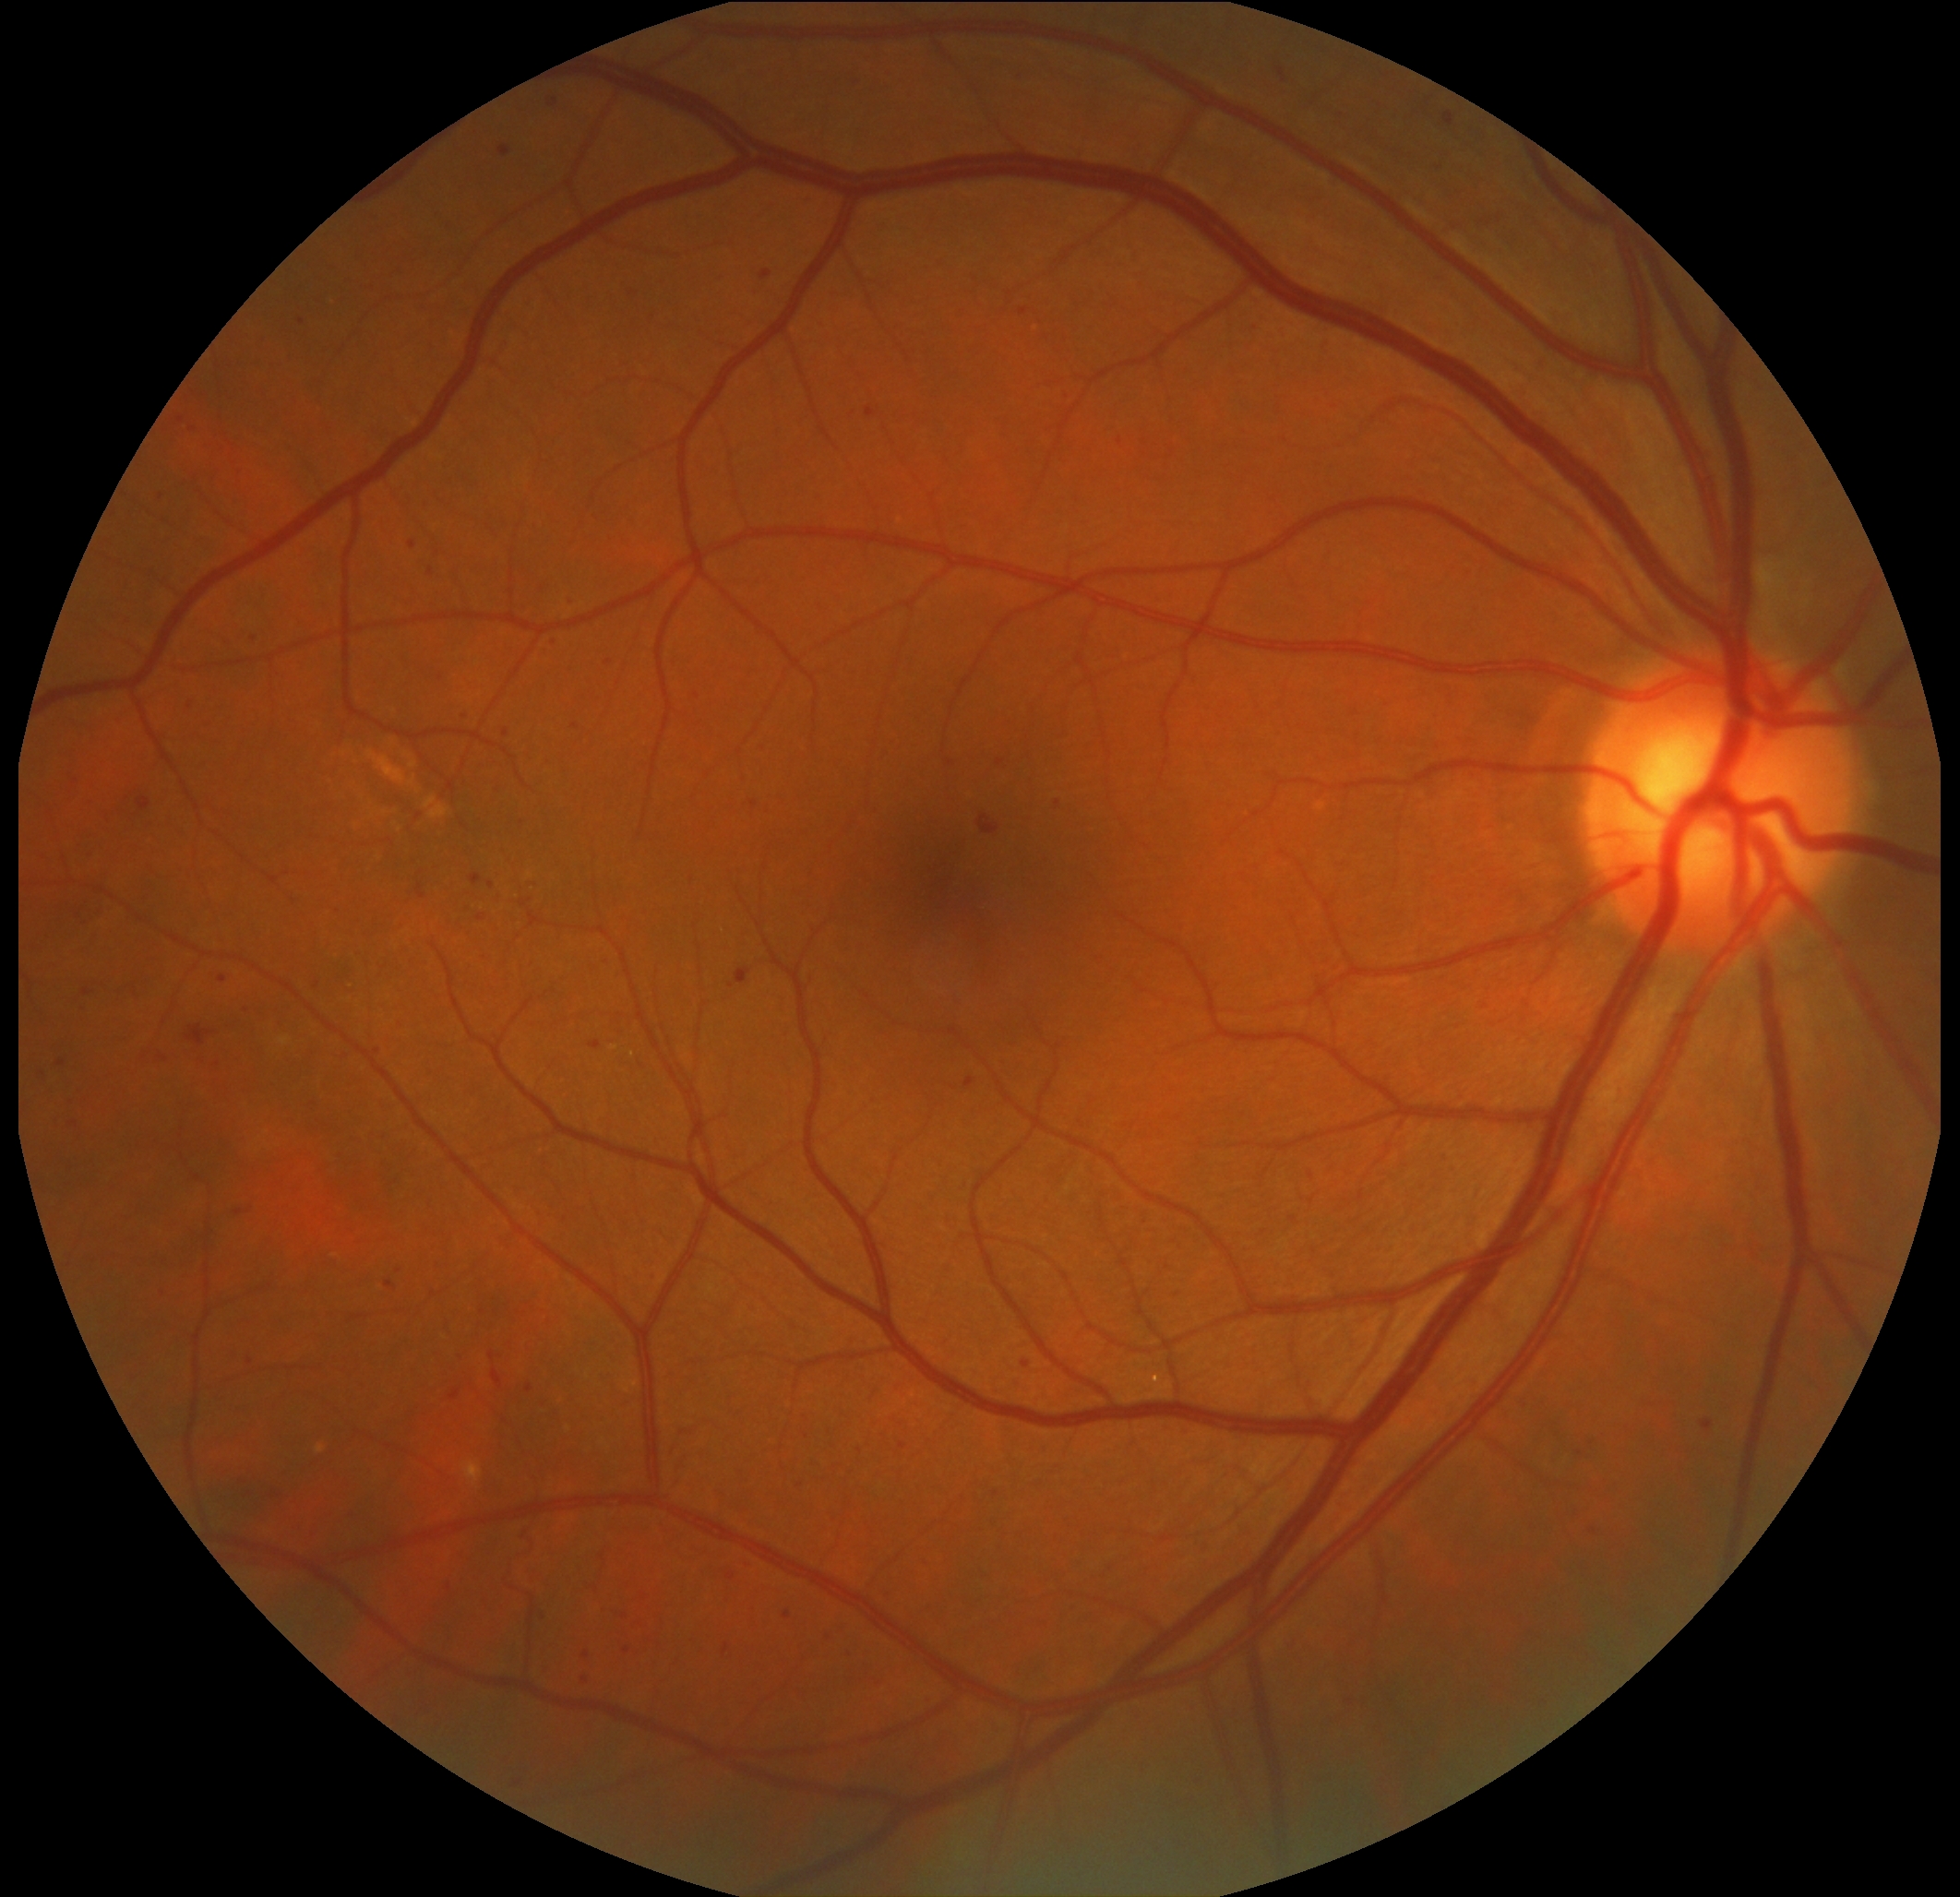 DR is grade 2 (moderate NPDR).